Fundus photo. FOV: 45 degrees. 2352 by 1568 pixels
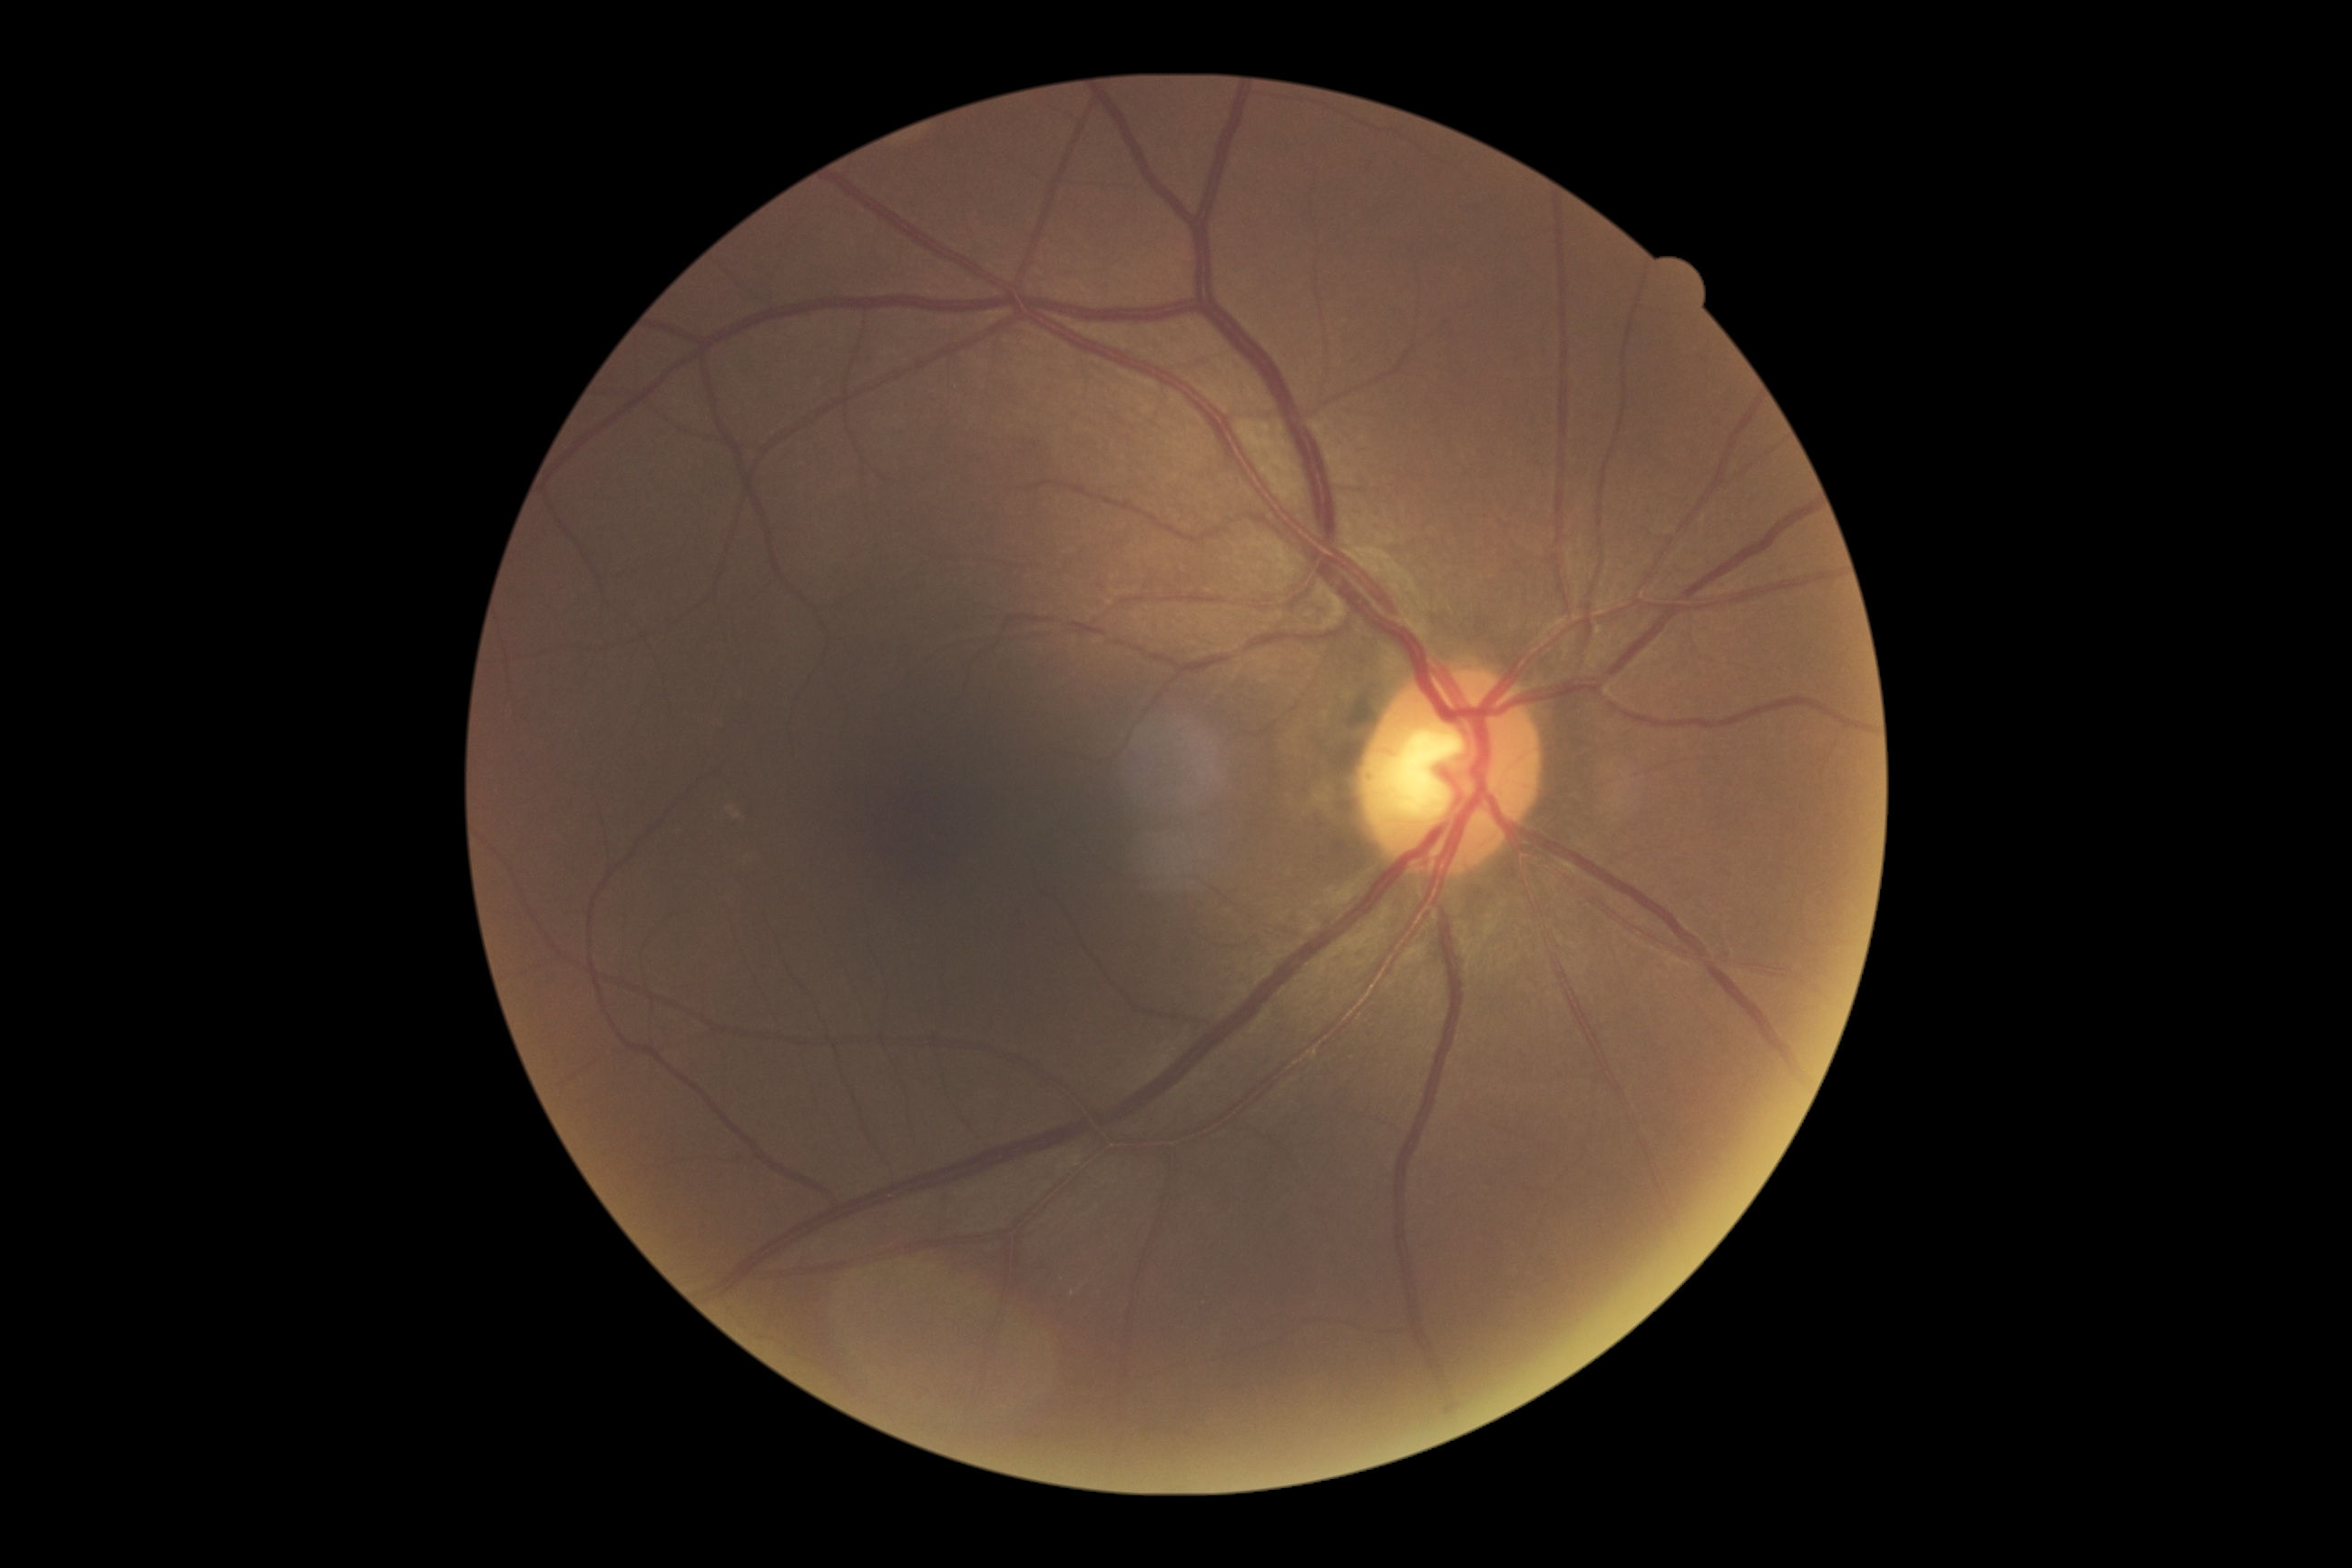 DR stage: grade 0.